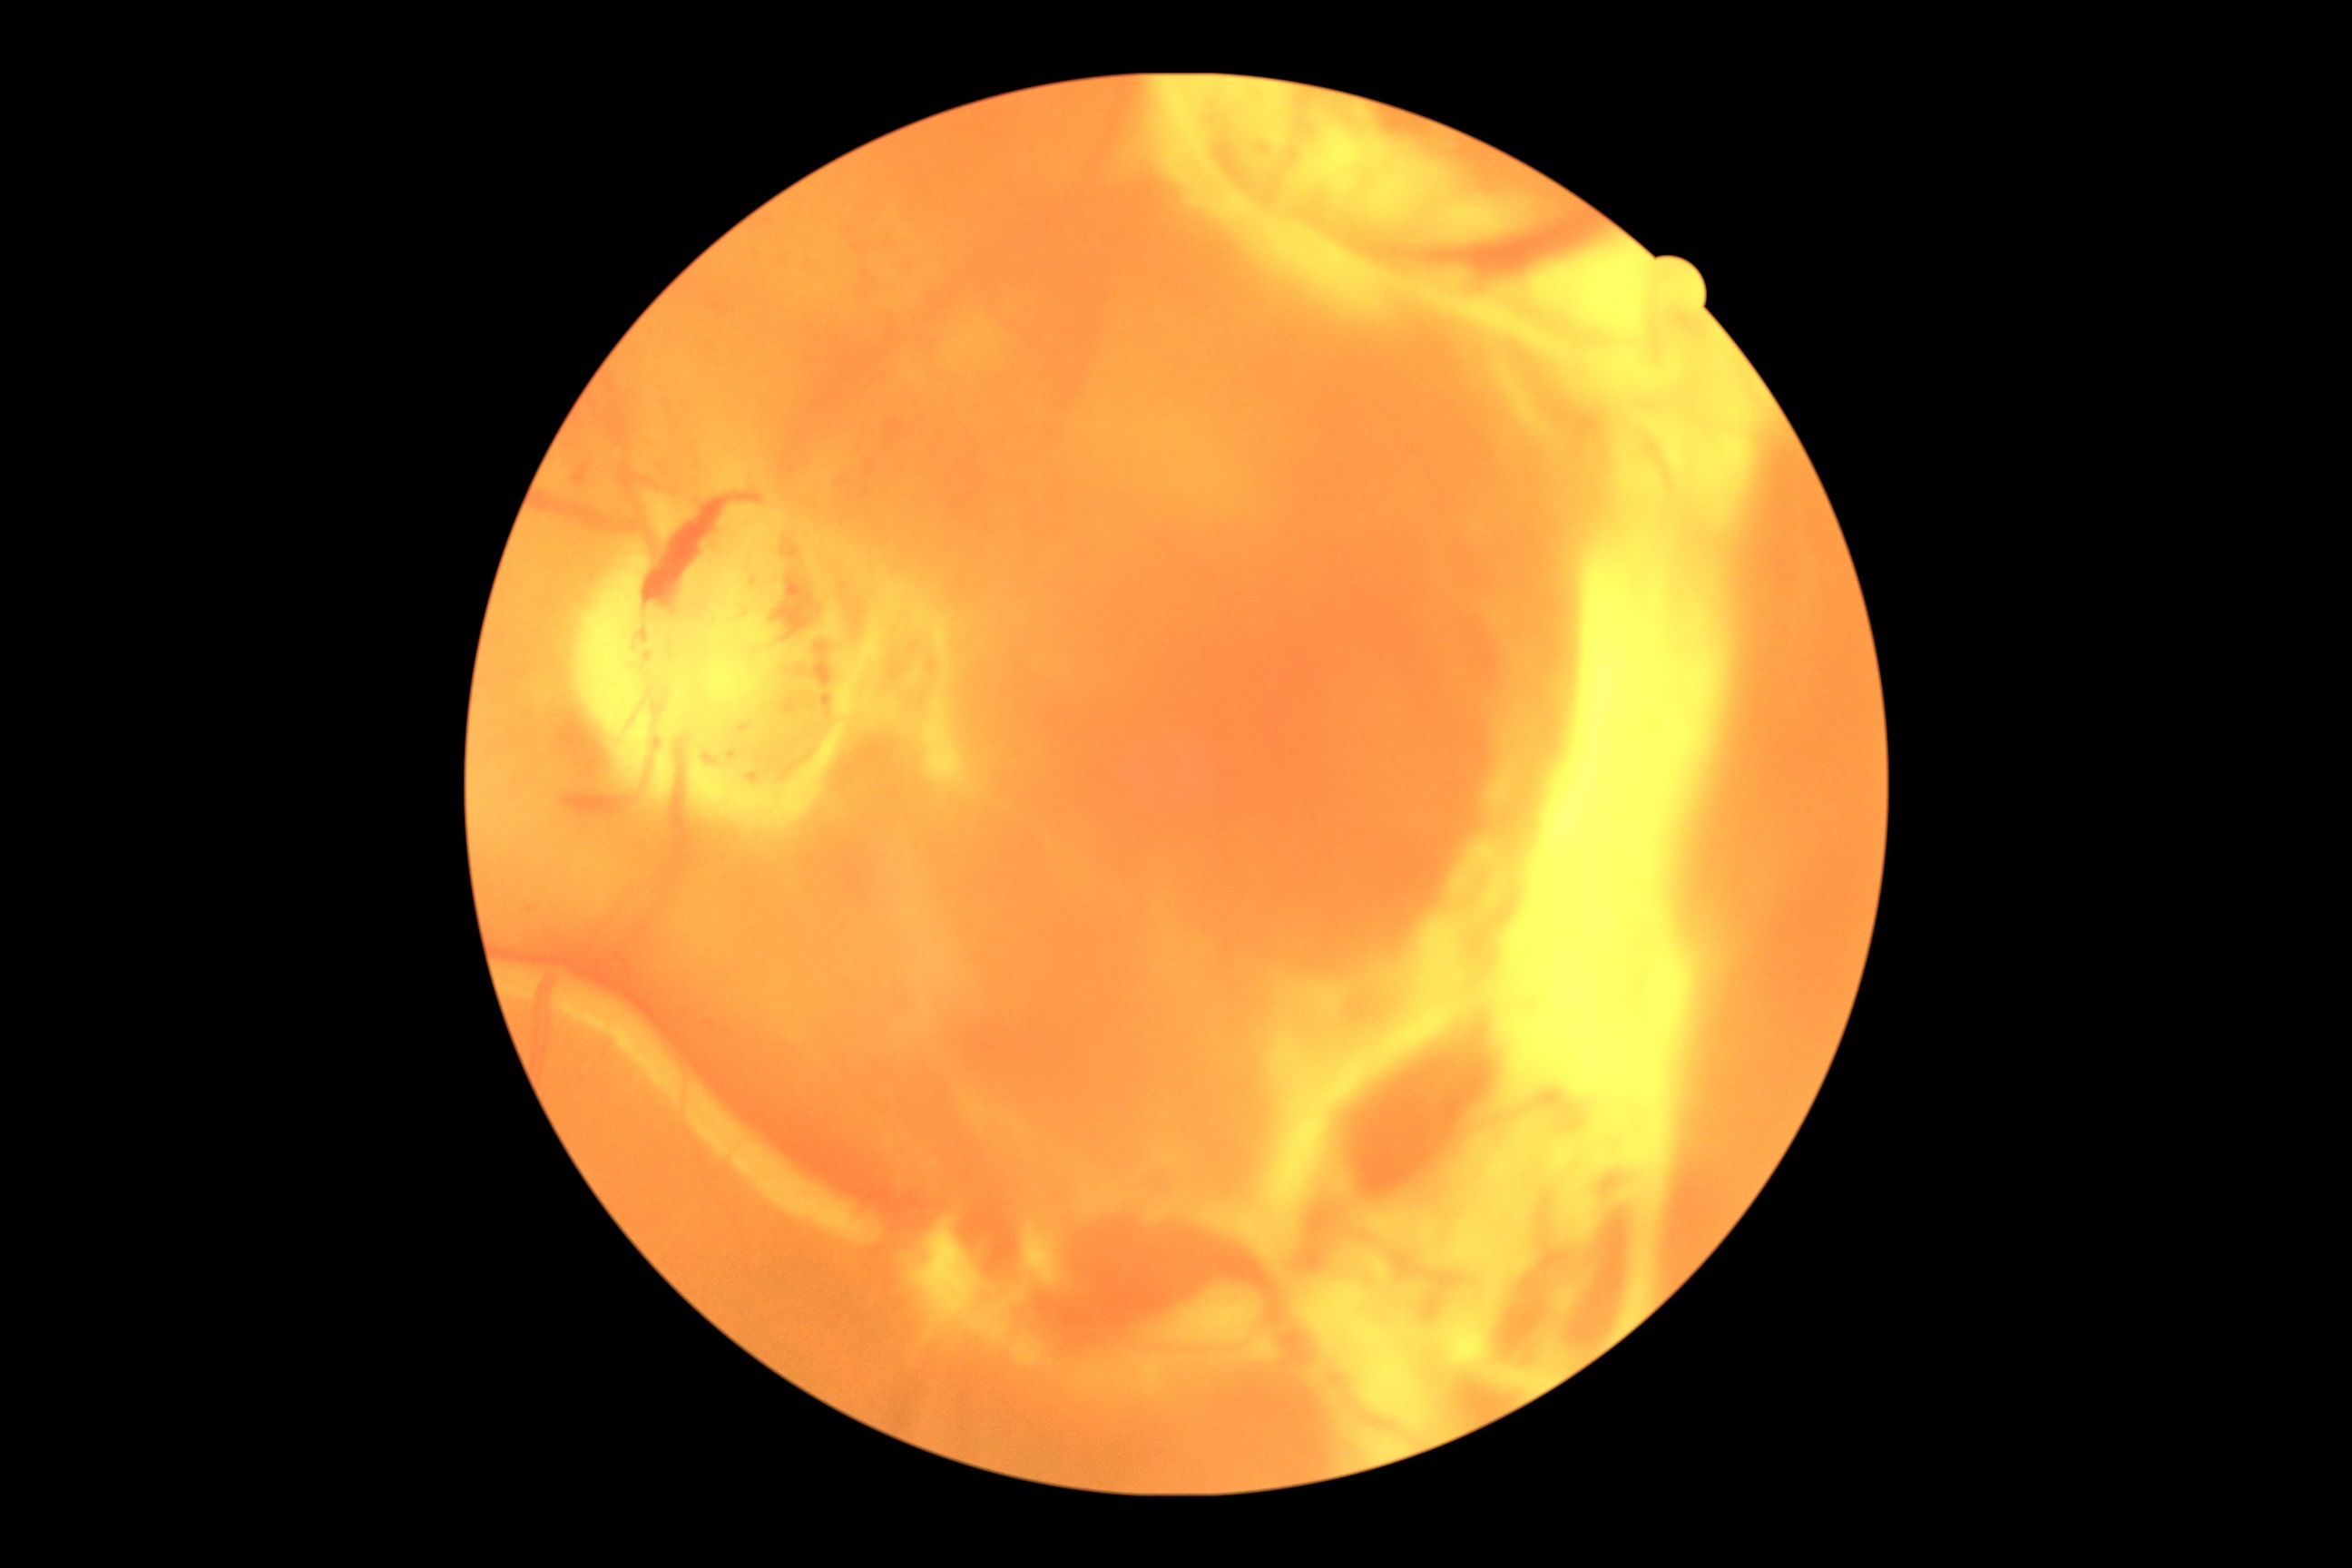 retinopathy@4/4.